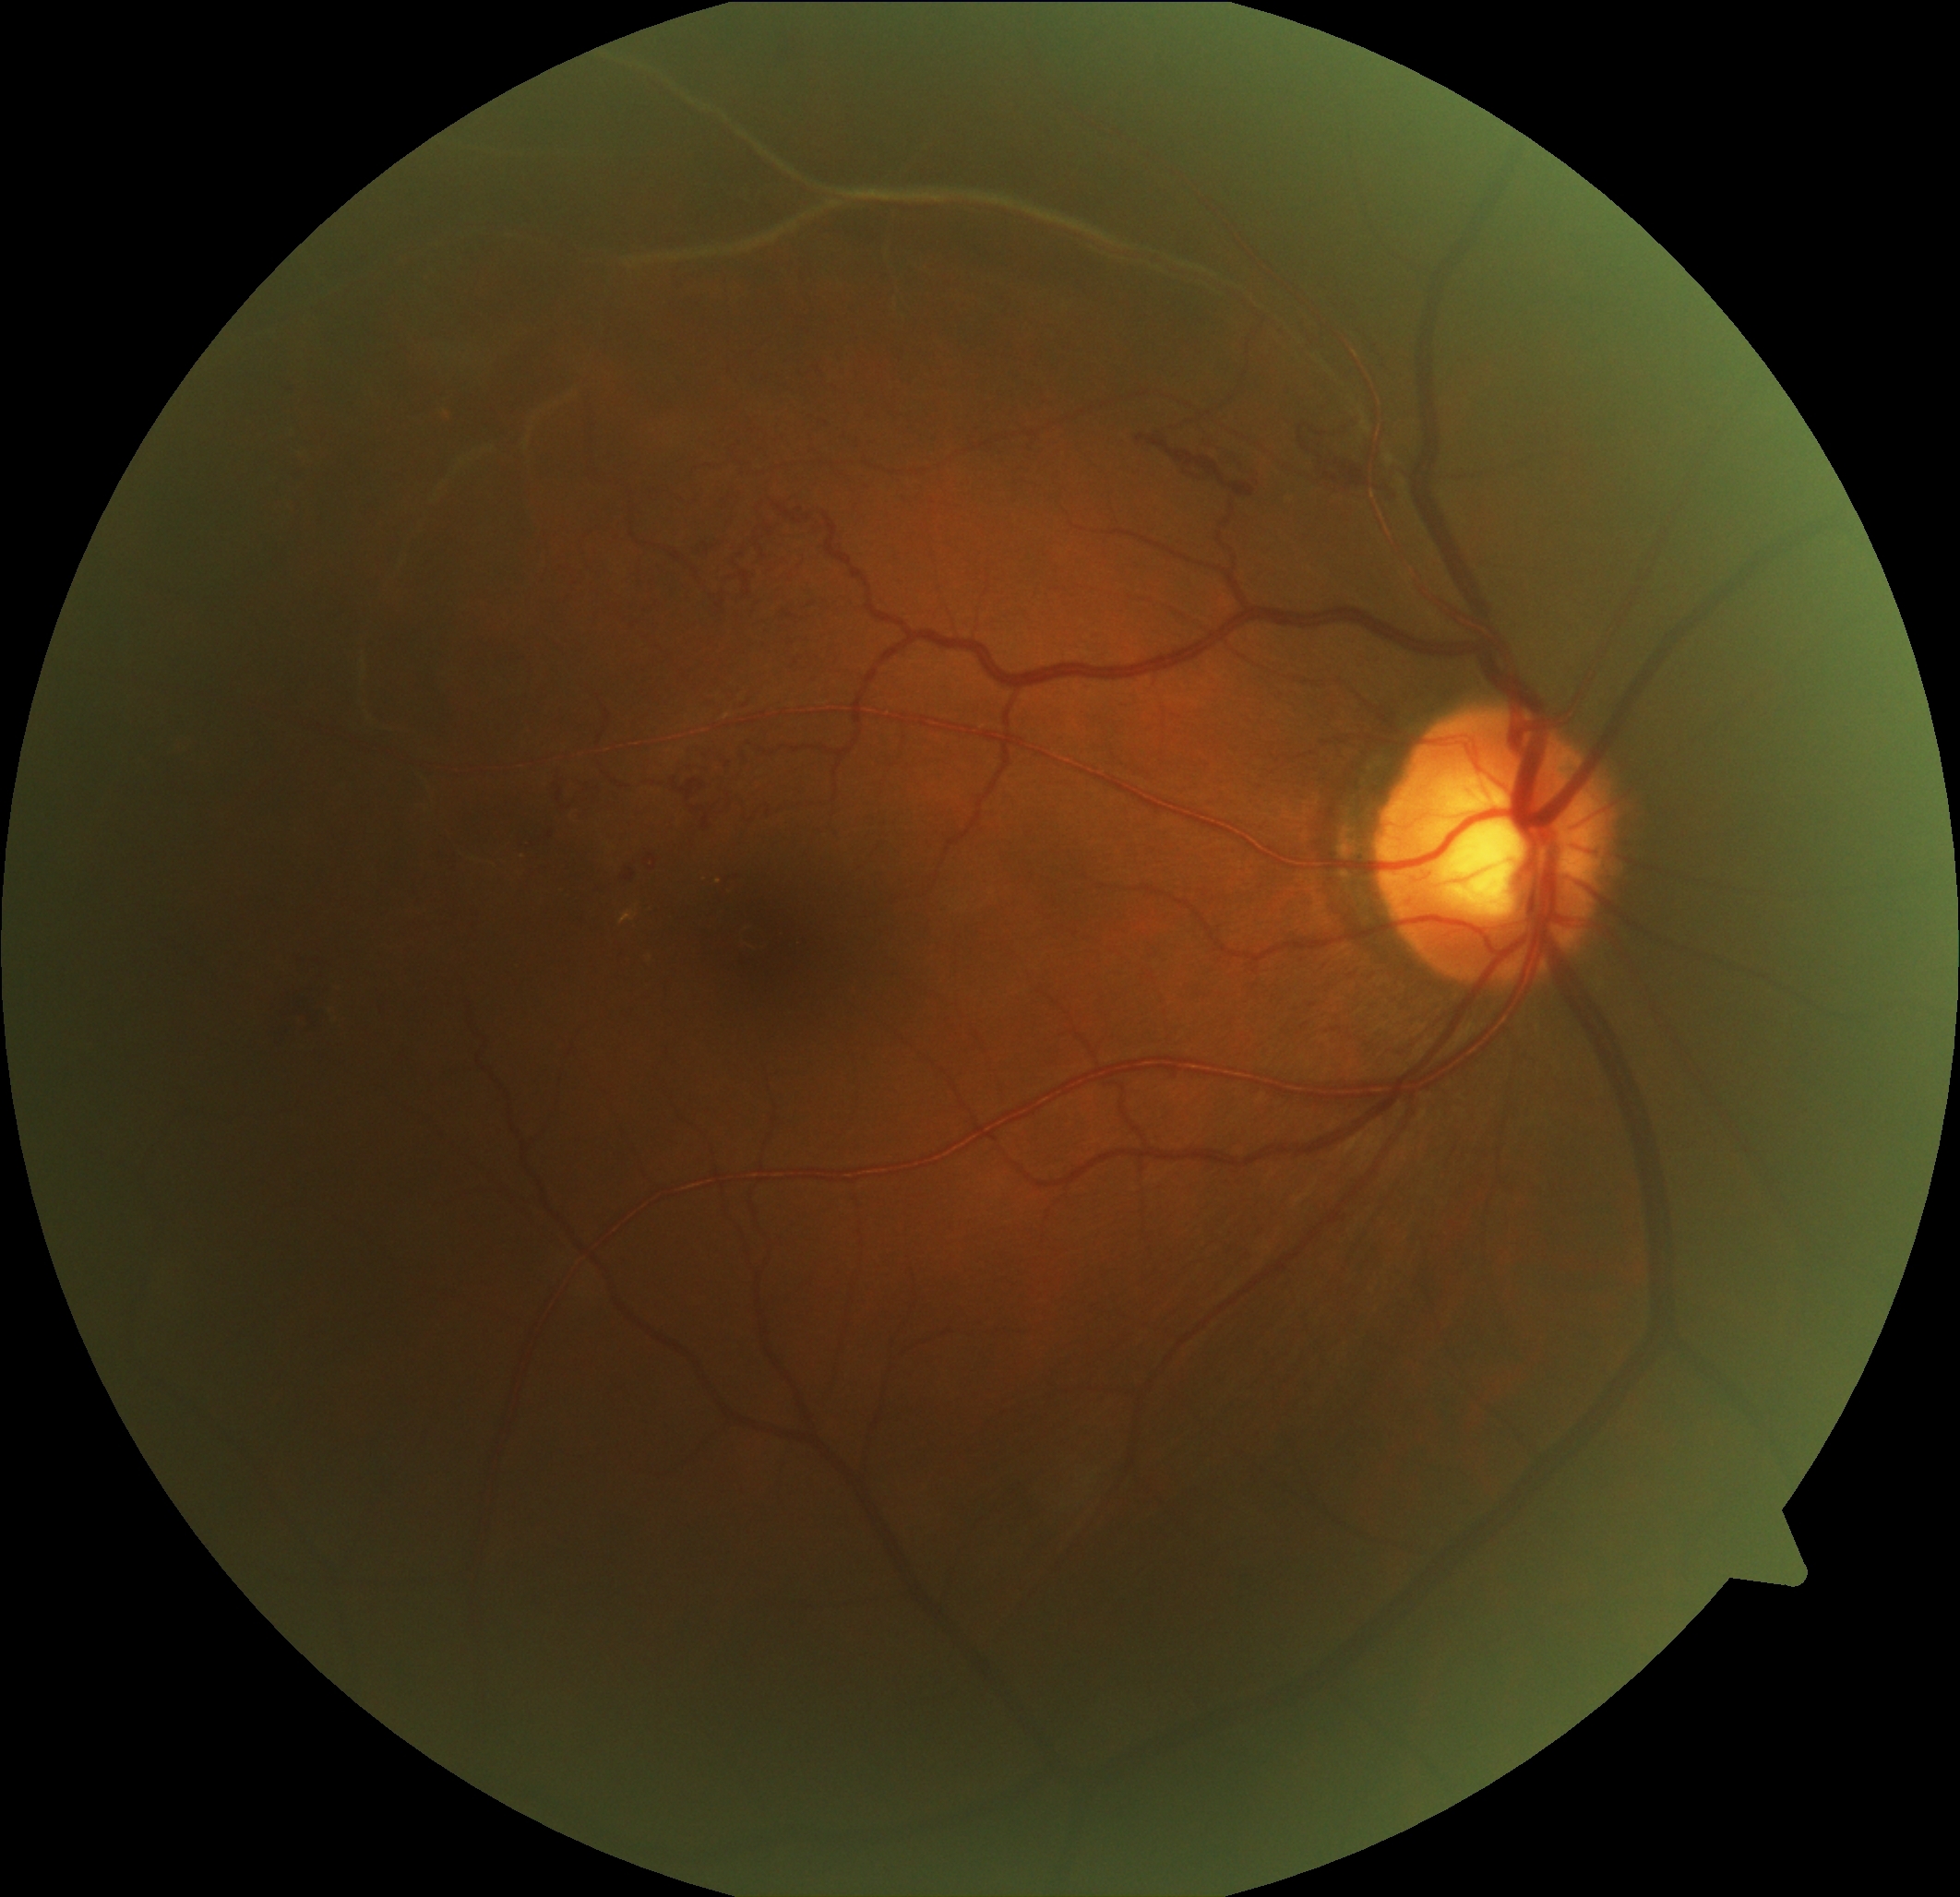
Disease class: proliferative diabetic retinopathy. DR severity: PDR (grade 4).